Nonmydriatic: 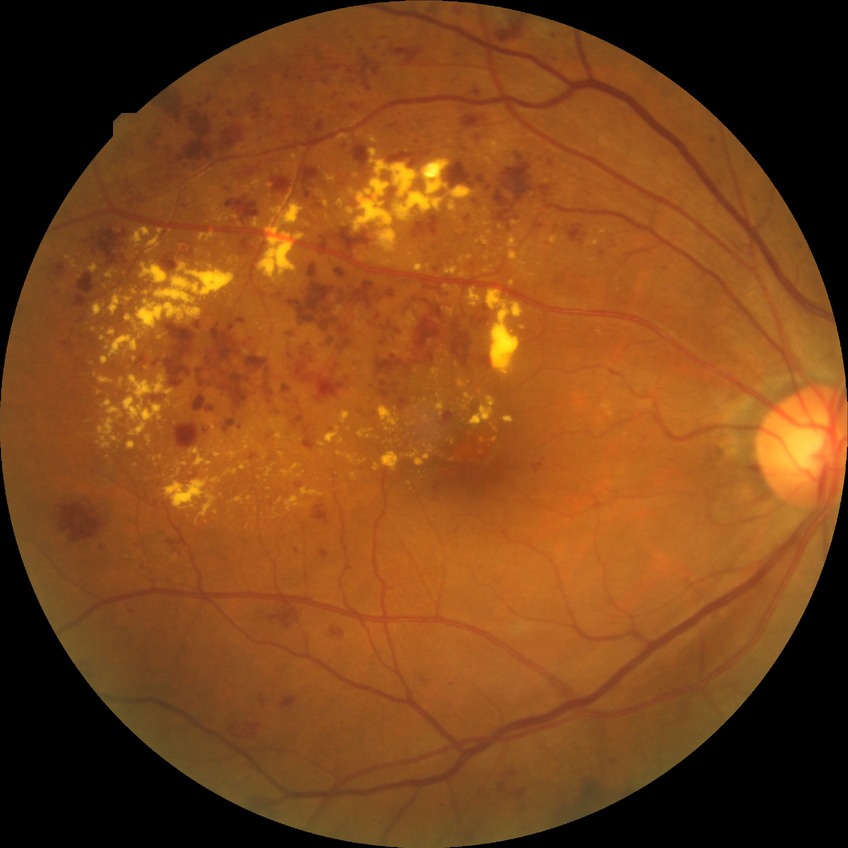

davis_grade: PDR (proliferative diabetic retinopathy)